Modified Davis grading
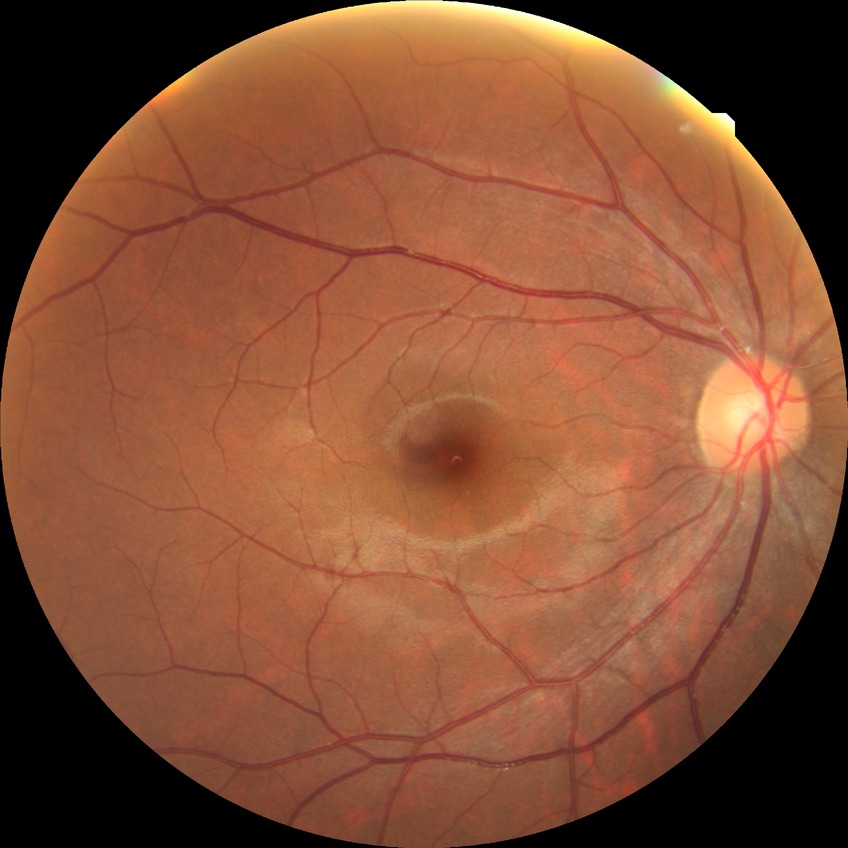 Diabetic retinopathy grade is no diabetic retinopathy.